Retinal fundus photograph · image size 2352x1568:
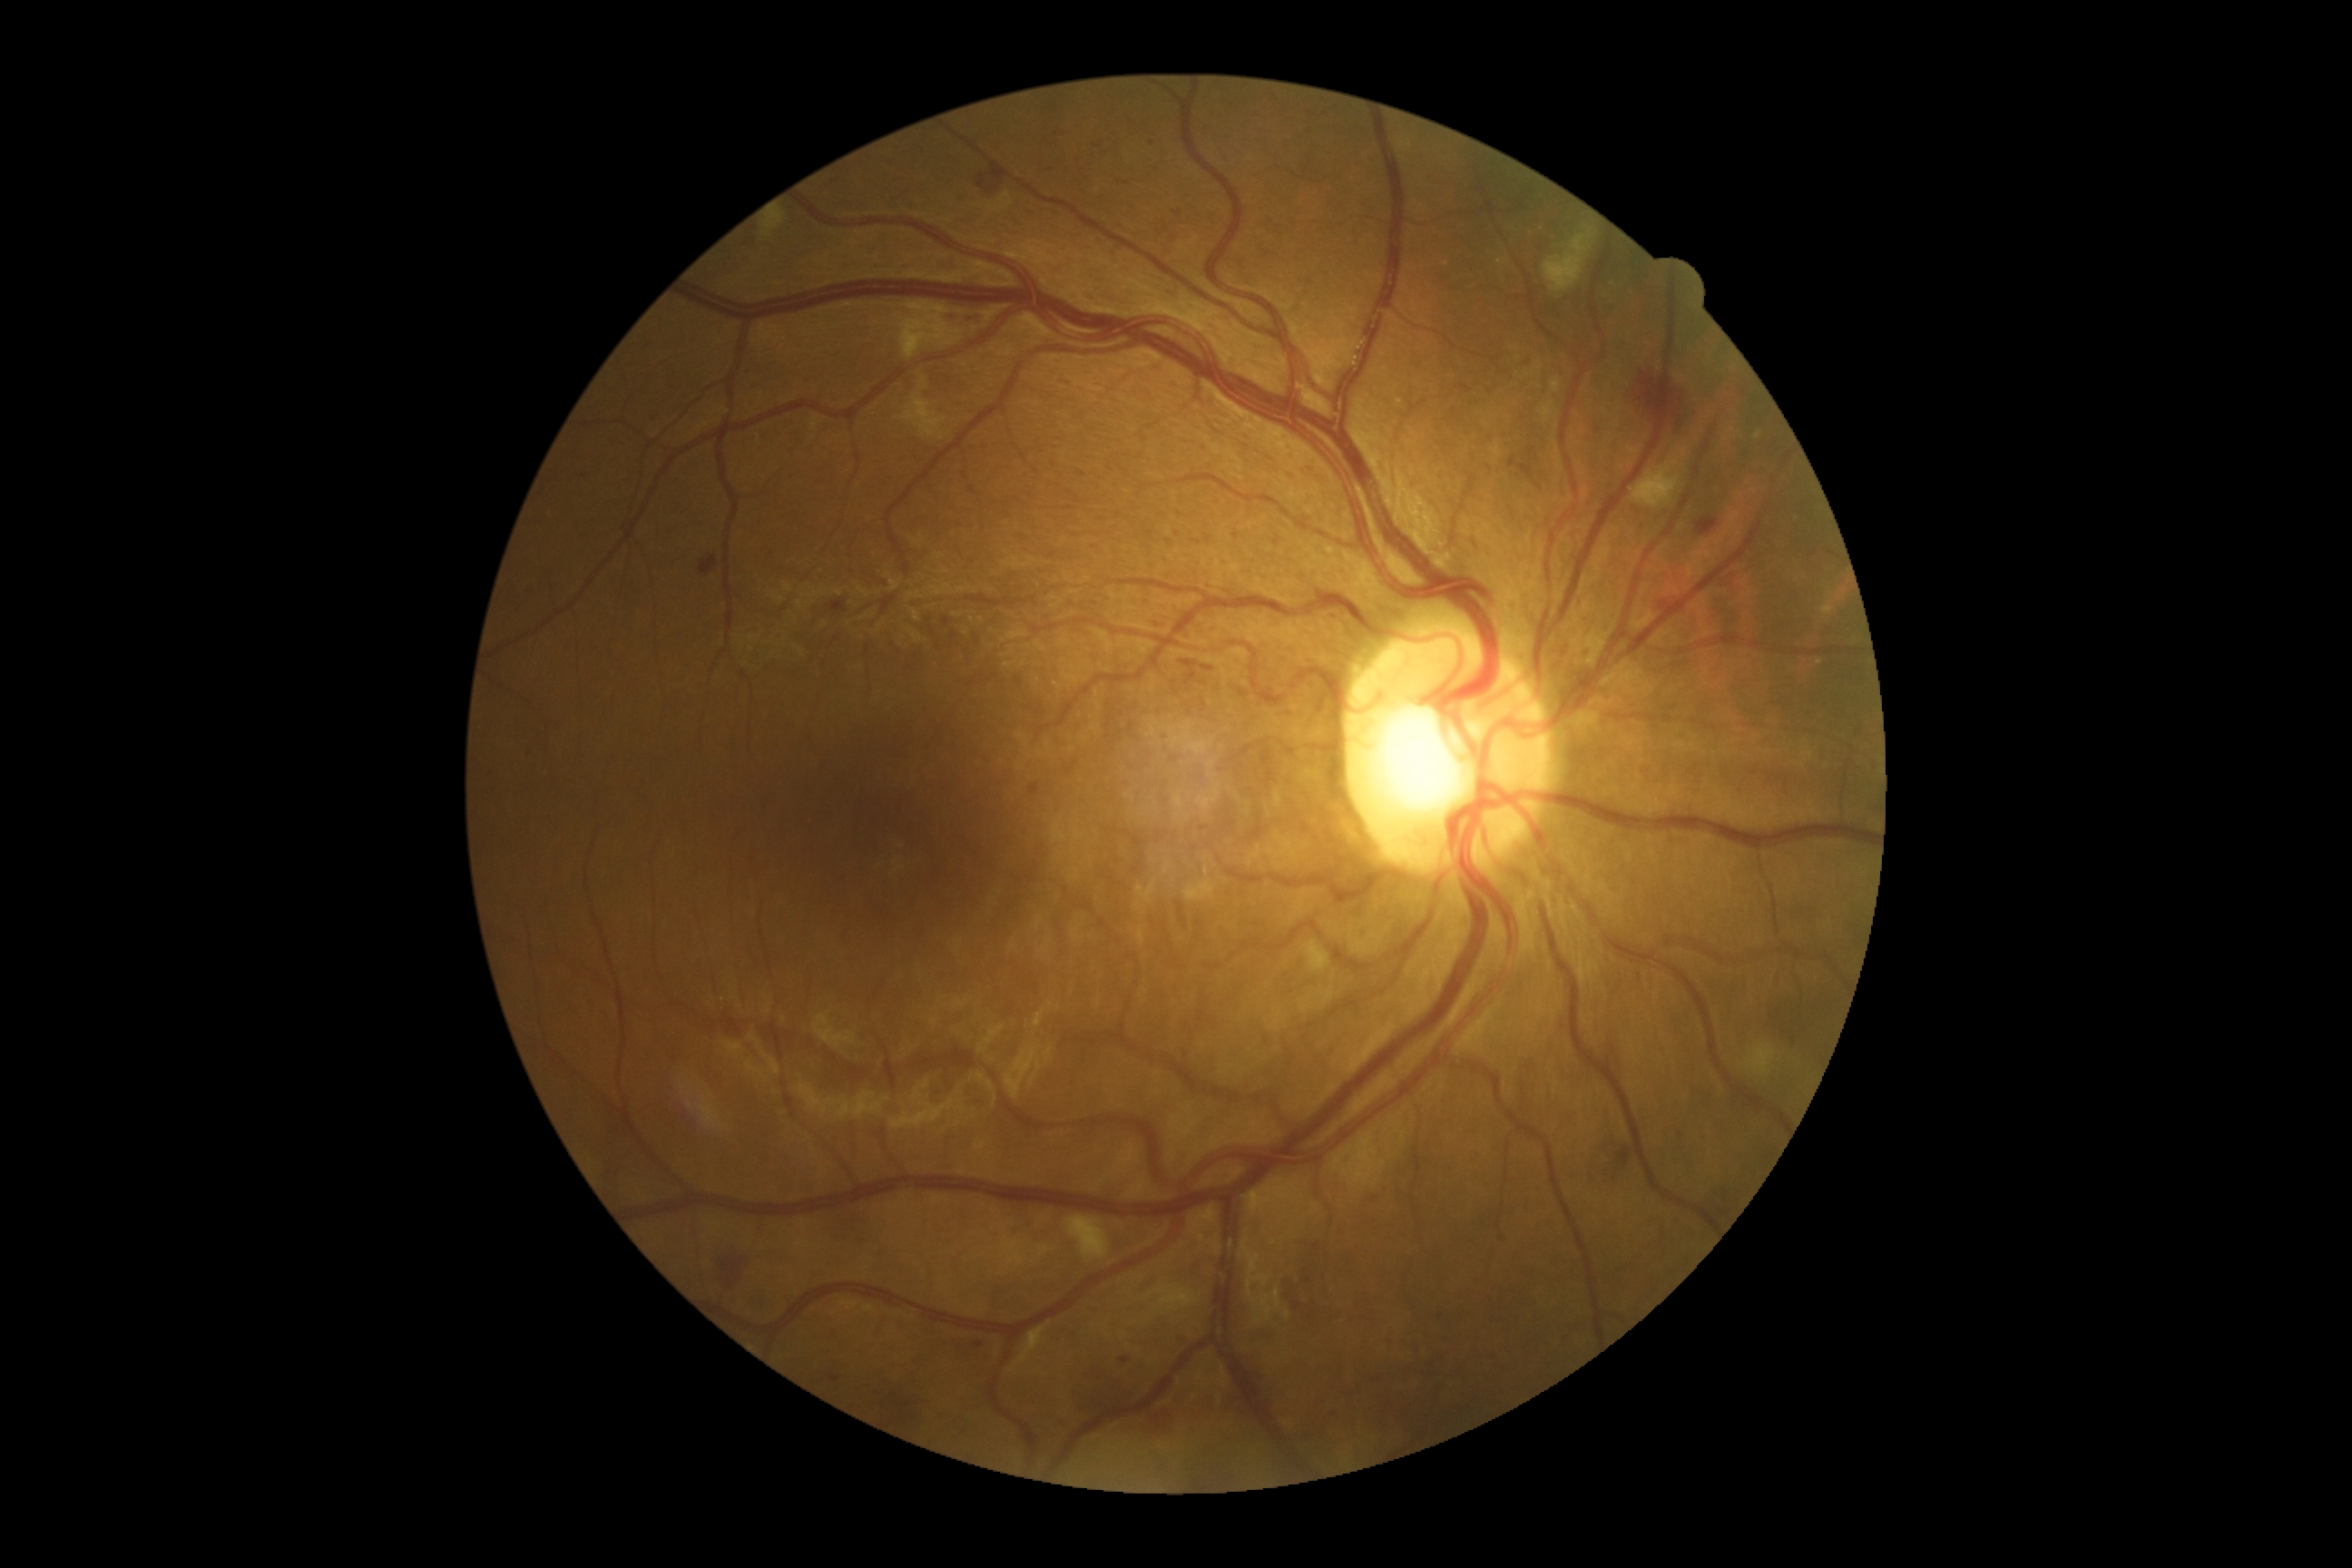

DR is grade 2 — more than just microaneurysms but less than severe NPDR. The retinopathy is classified as non-proliferative diabetic retinopathy.